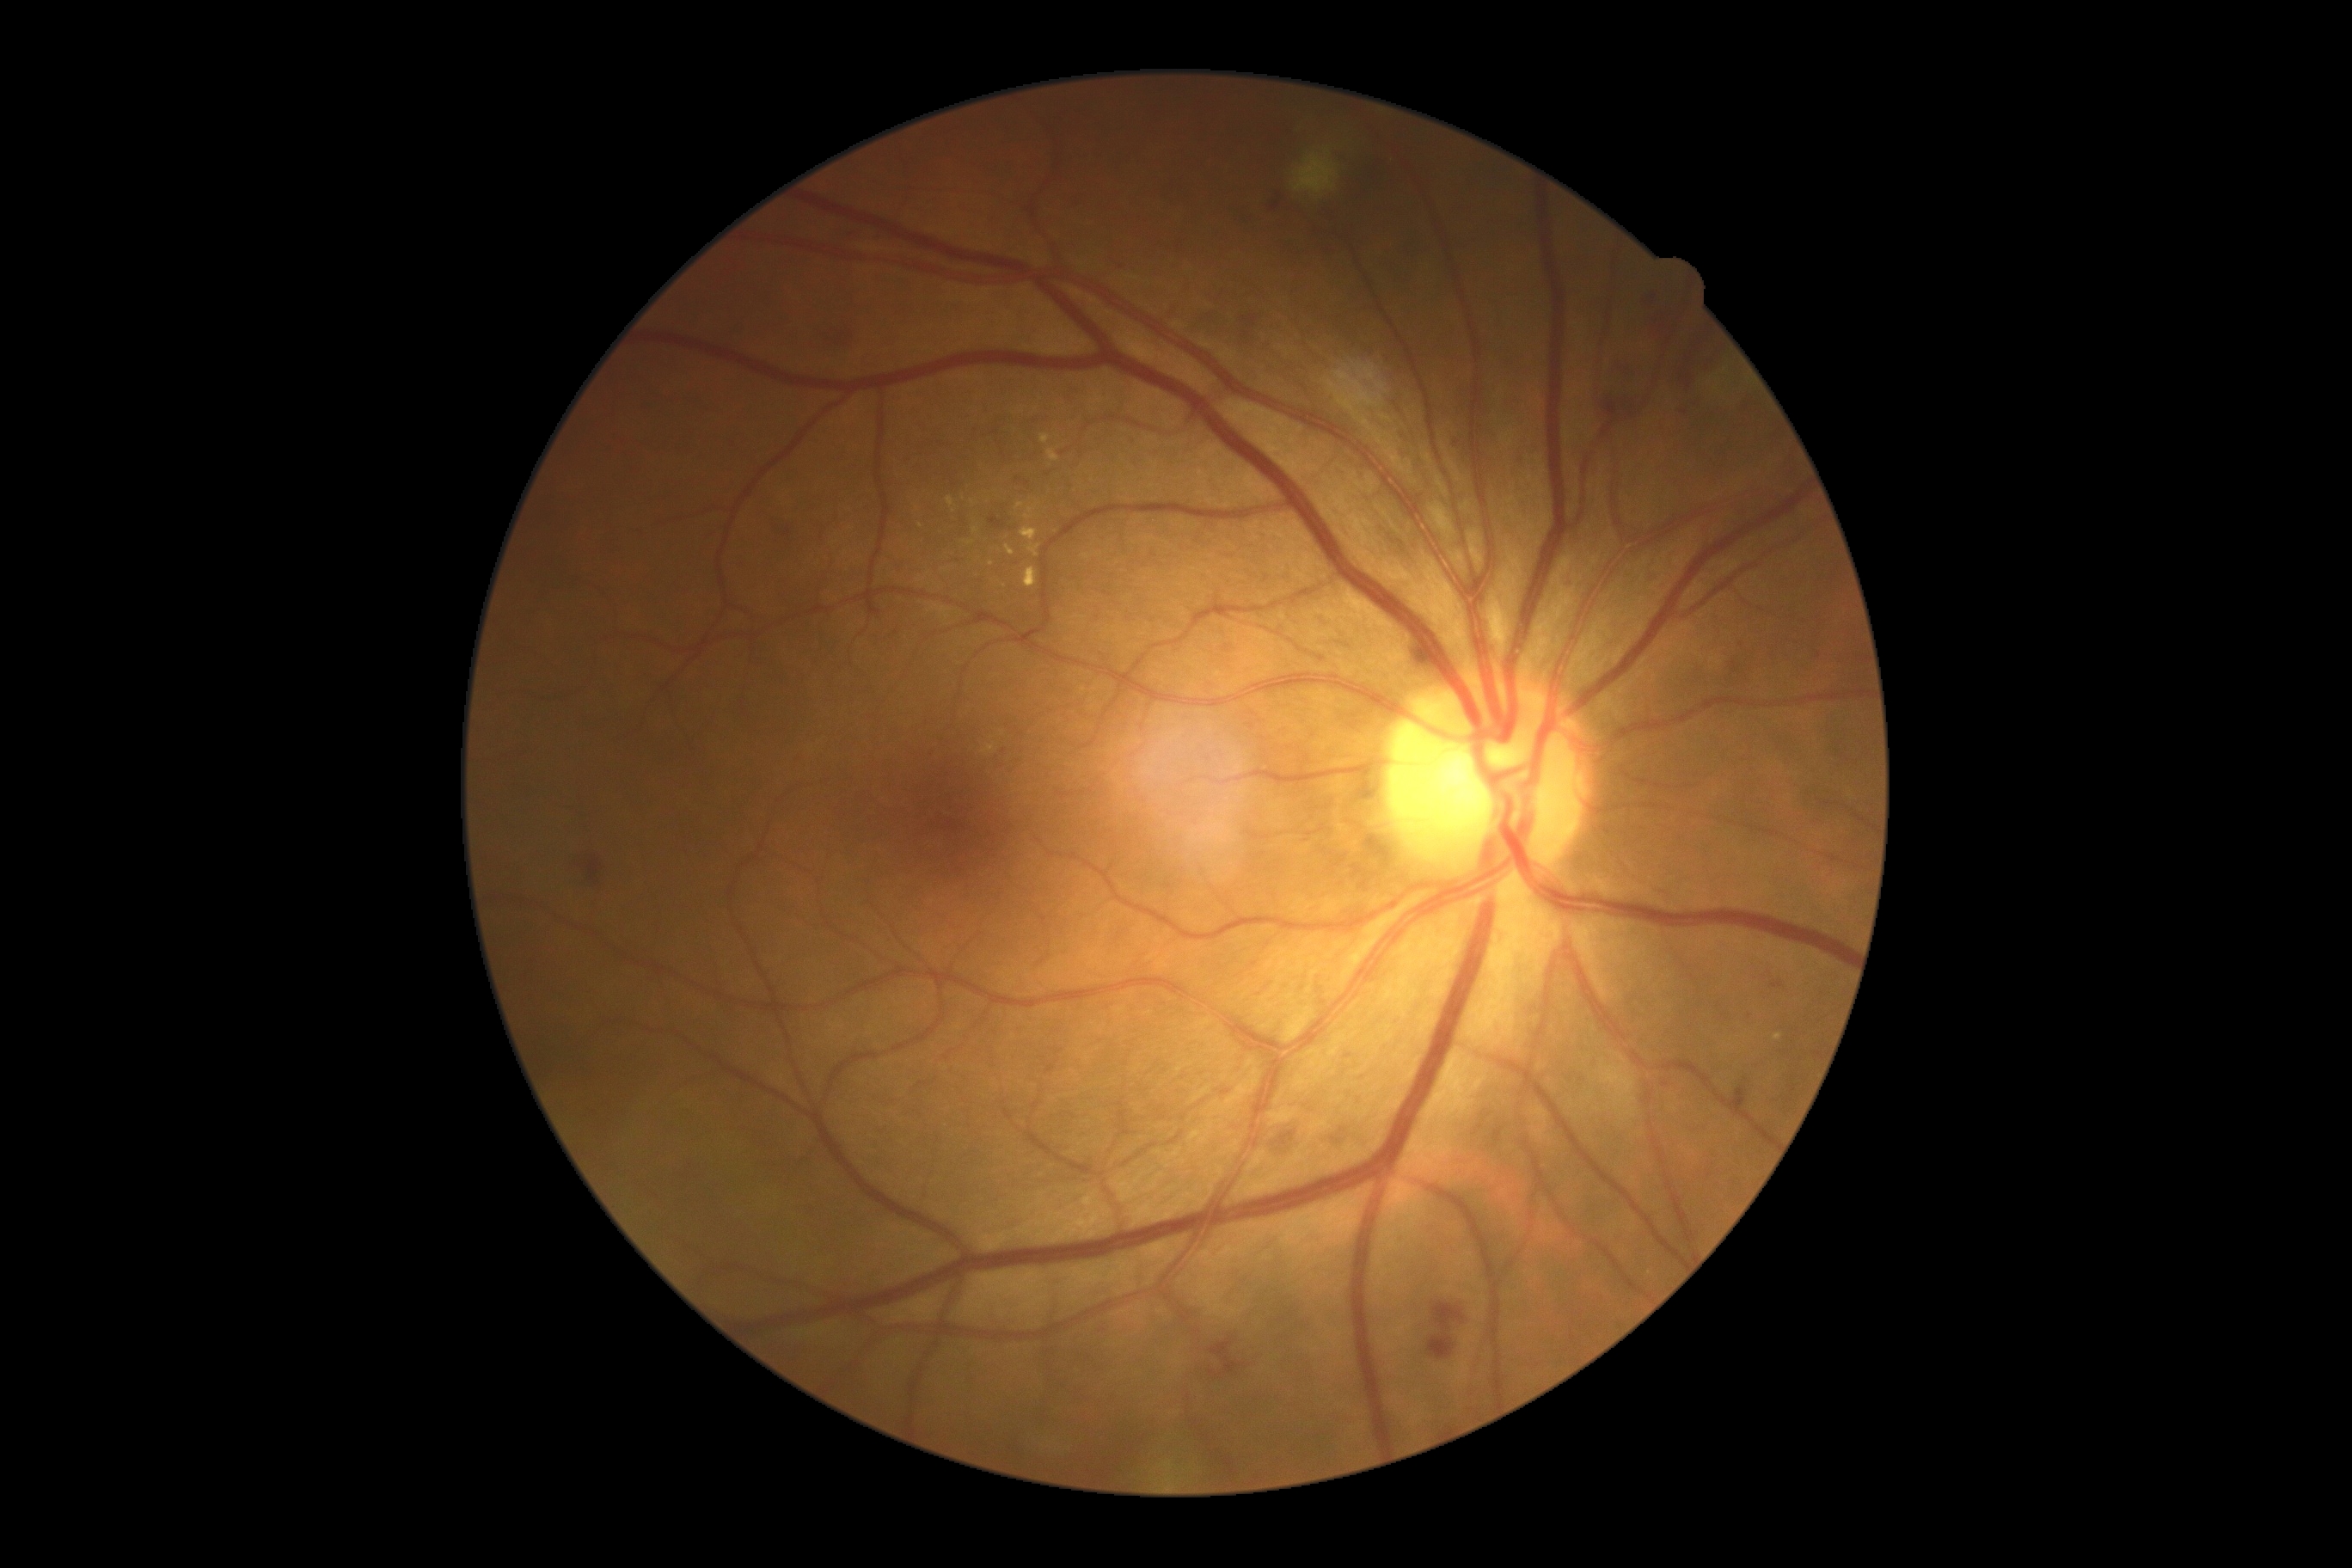
diabetic retinopathy (DR) = moderate NPDR (grade 2).